Axial length (AL) 23.56 mm. 57 years old. Corneal thickness 535 µm. Non-mydriatic. Optic disc-centered. Intraocular pressure (IOP) 24 mmHg. Retinal fundus photograph.
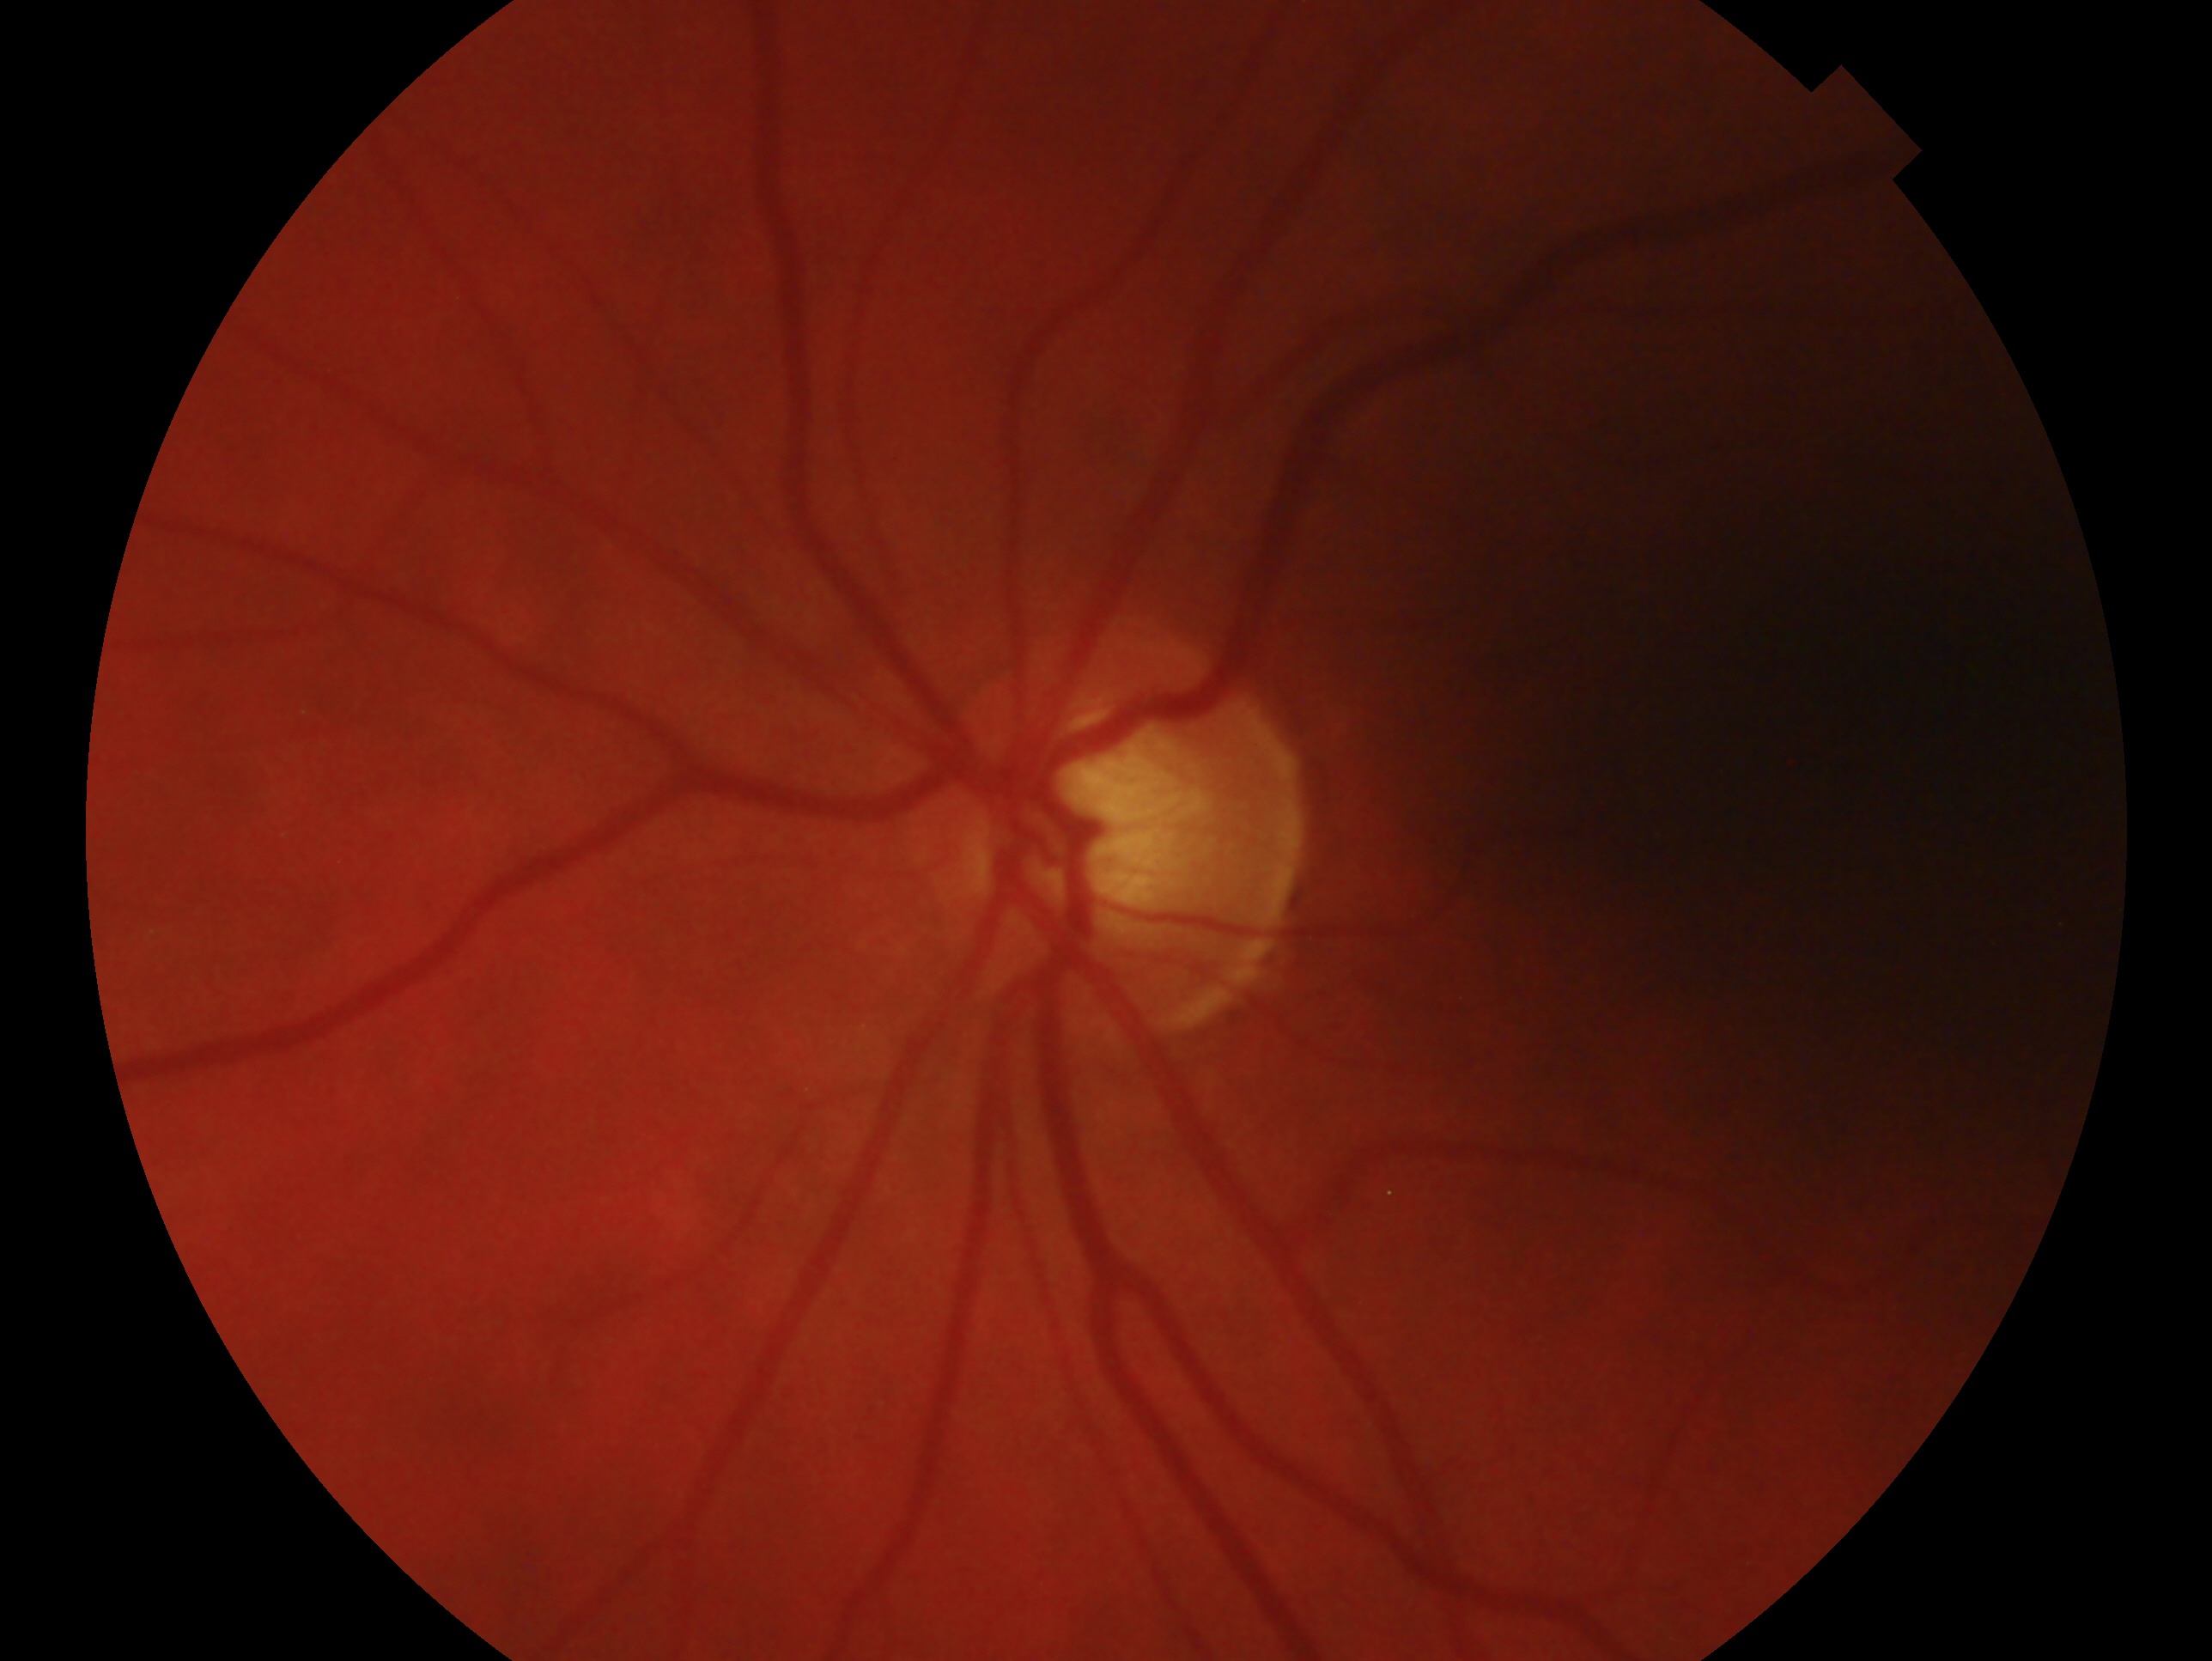

Eye: oculus sinister.
Assessment — possible glaucoma.